Non-mydriatic · 240 x 240 pixels · cropped to the optic nerve head
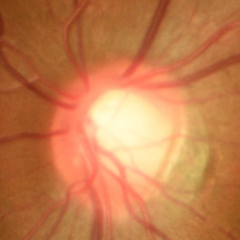

Color fundus photograph showing no evidence of glaucoma.